Image size 2048x1536.
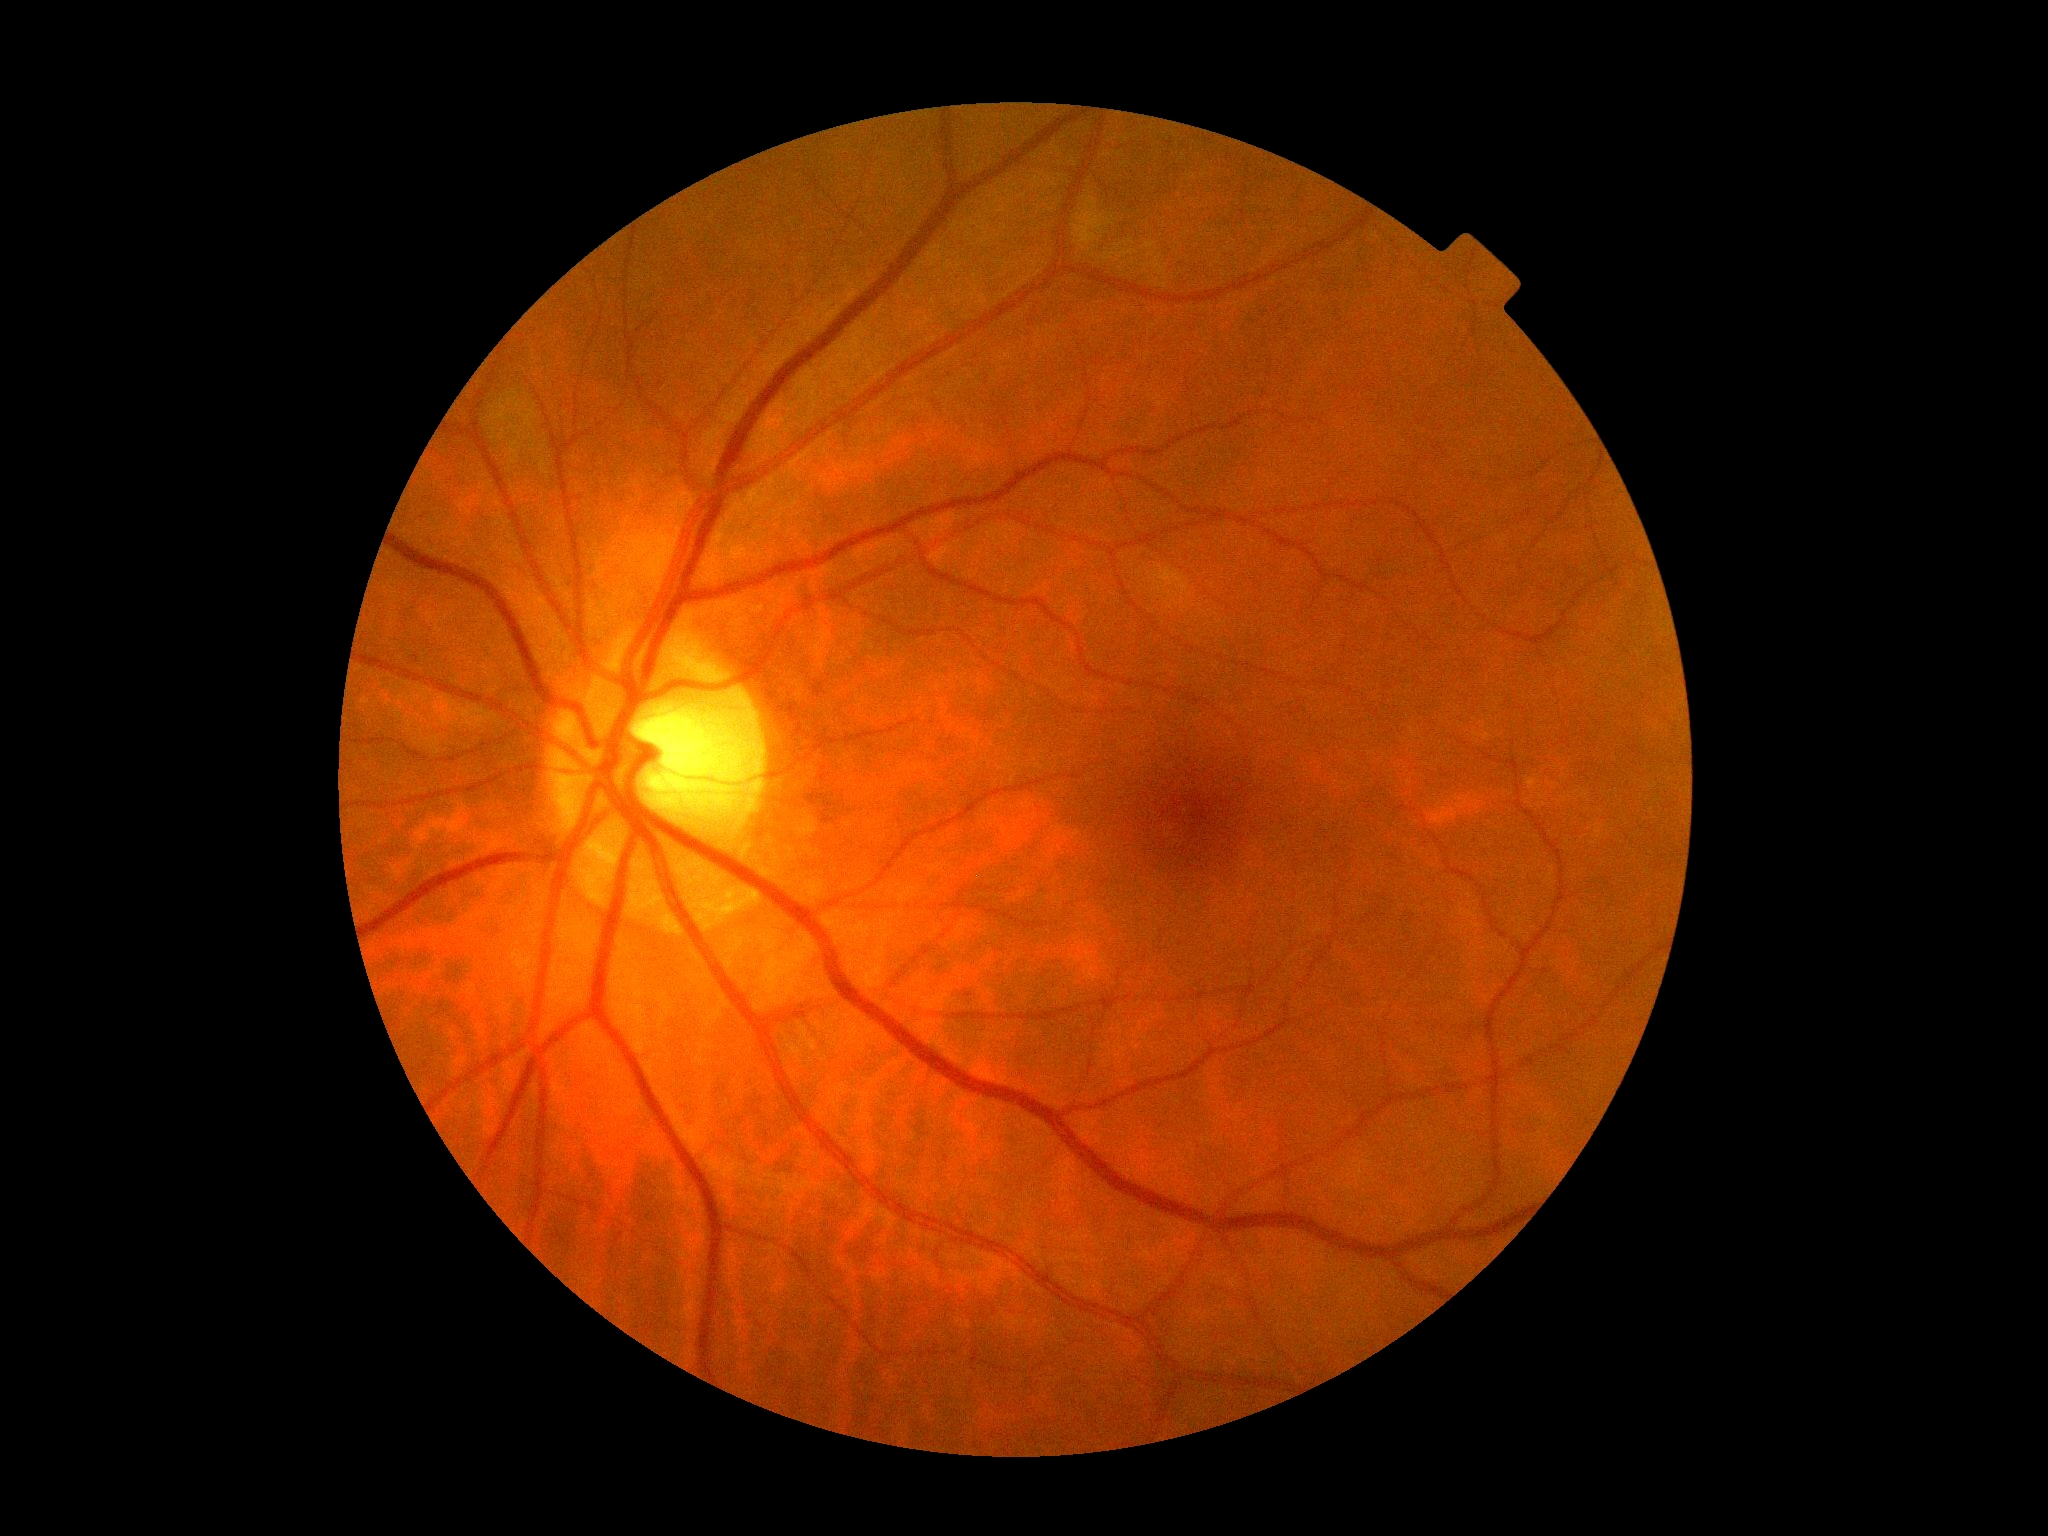

– DR grade: no apparent retinopathy (0)